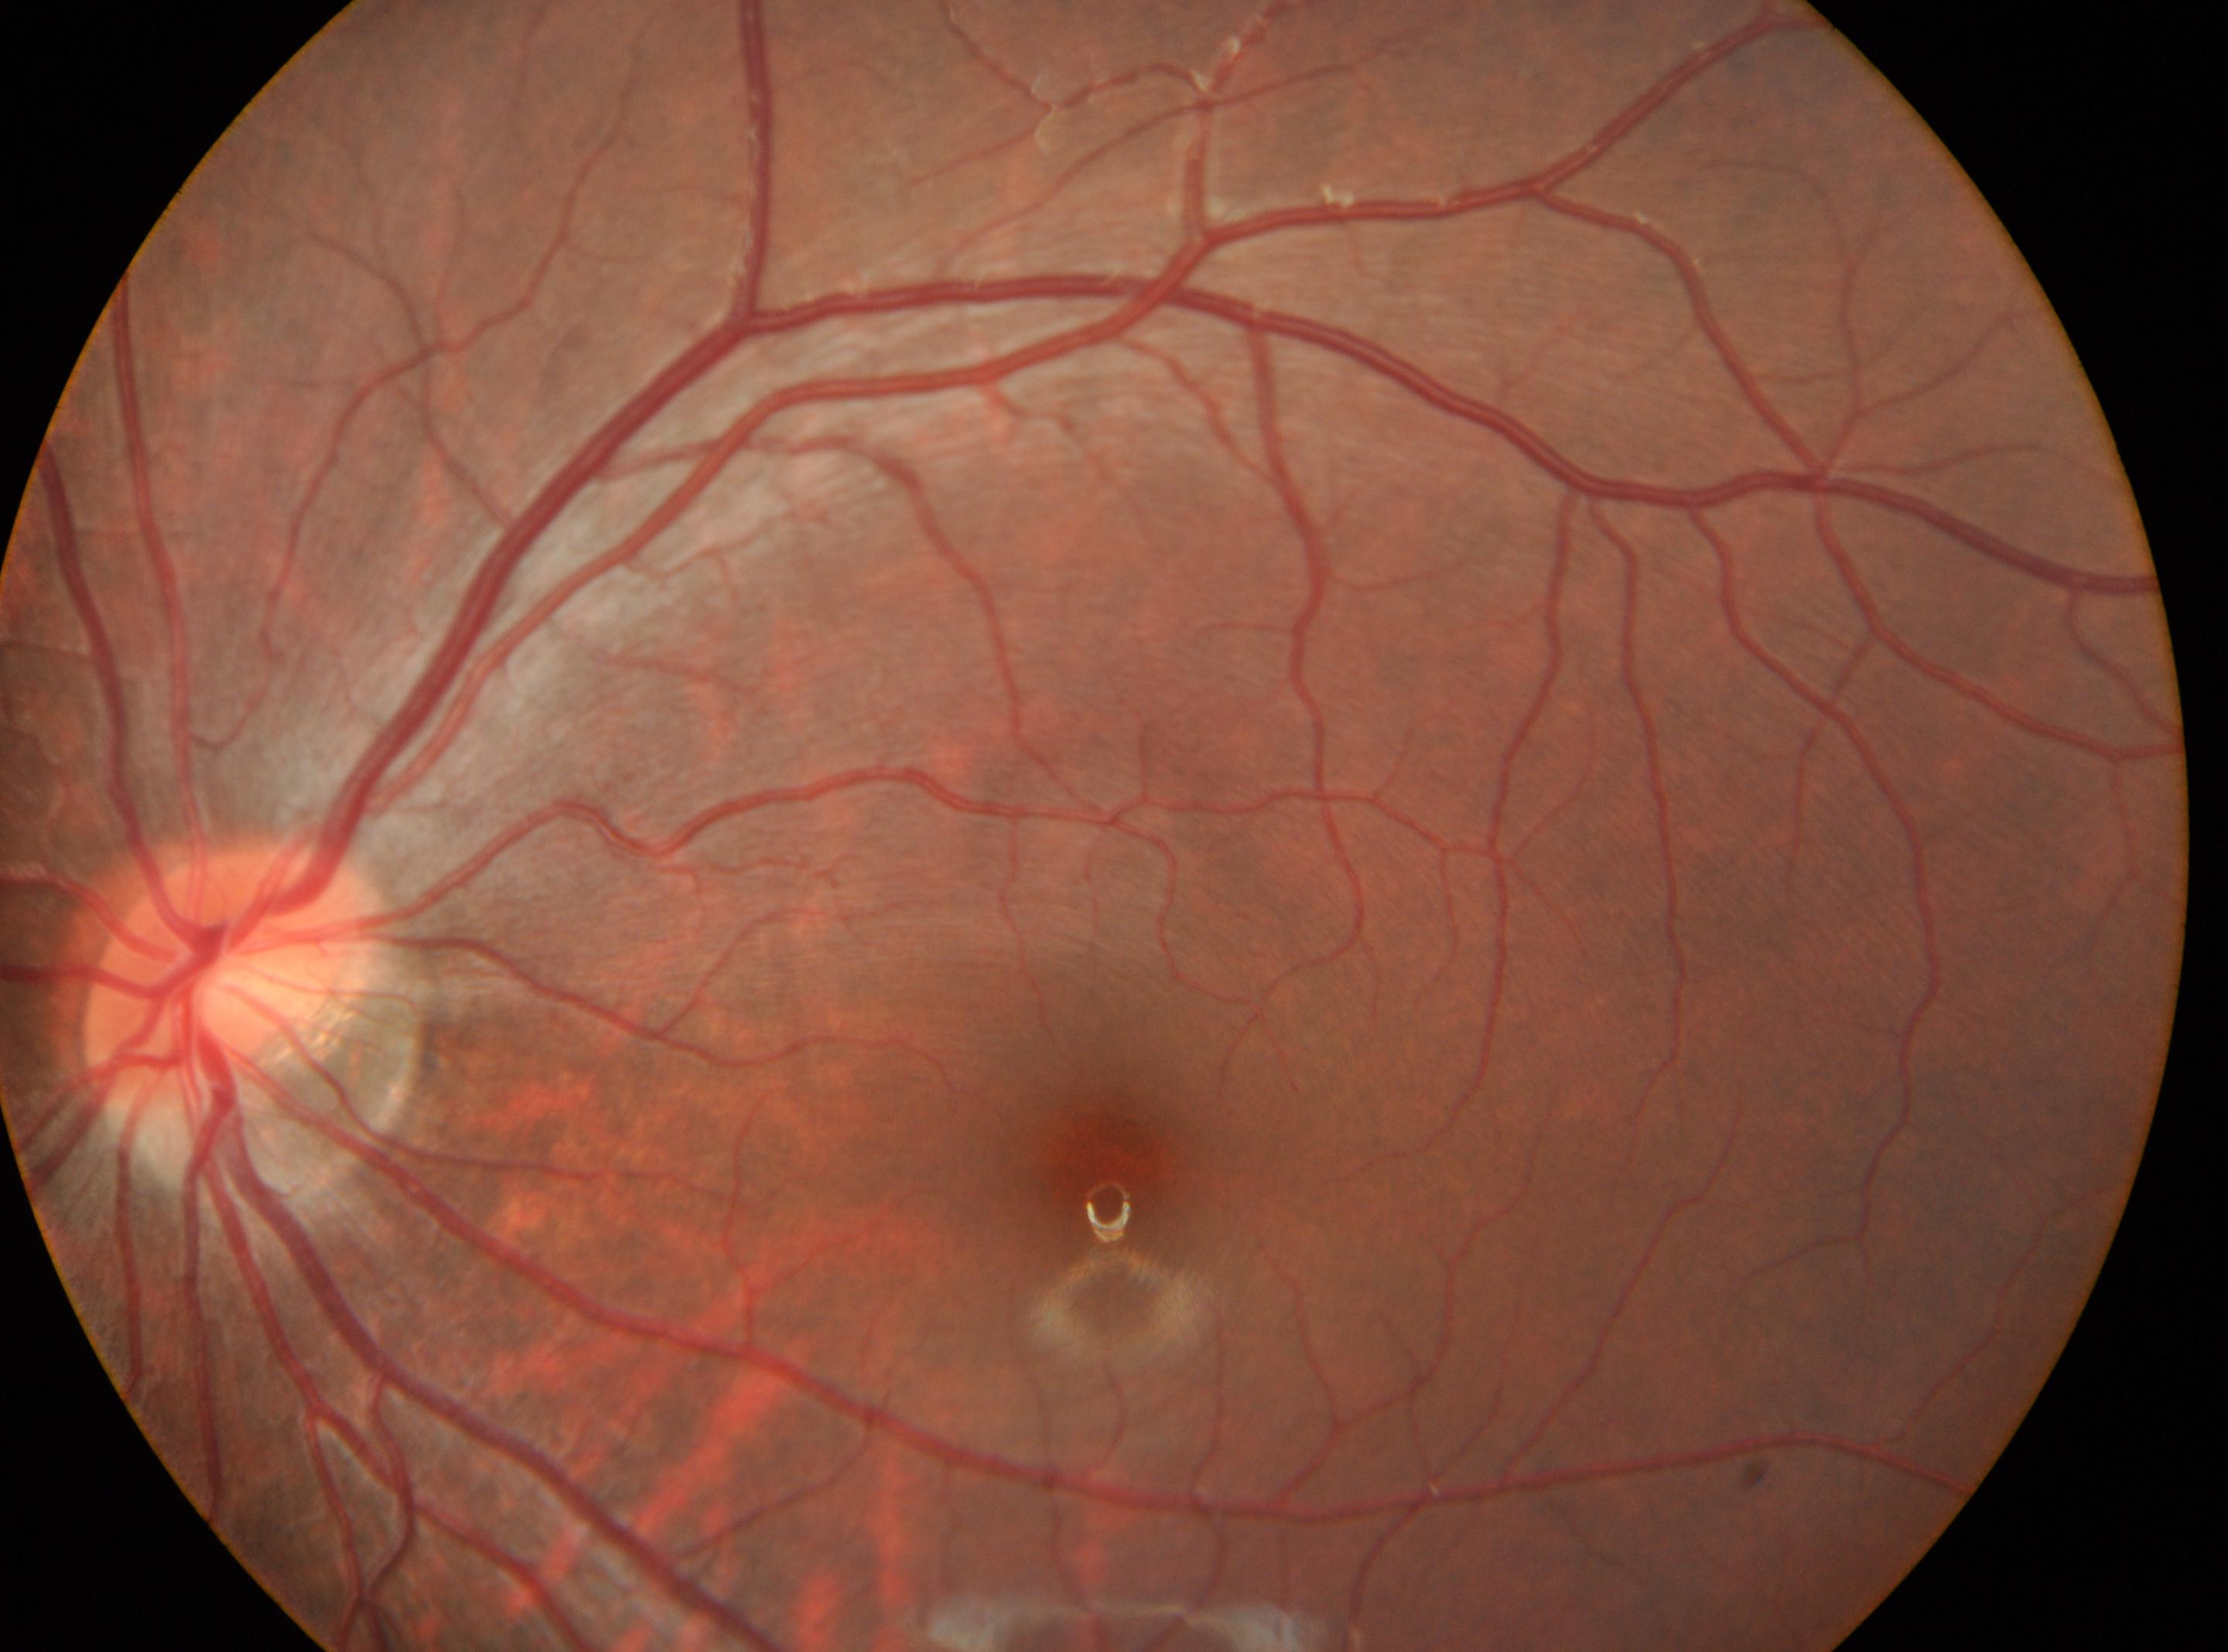
laterality = left, fovea = (x: 1111, y: 1174), optic disk = (x: 227, y: 971), DR = grade 0.